Wide-field fundus photograph of an infant — 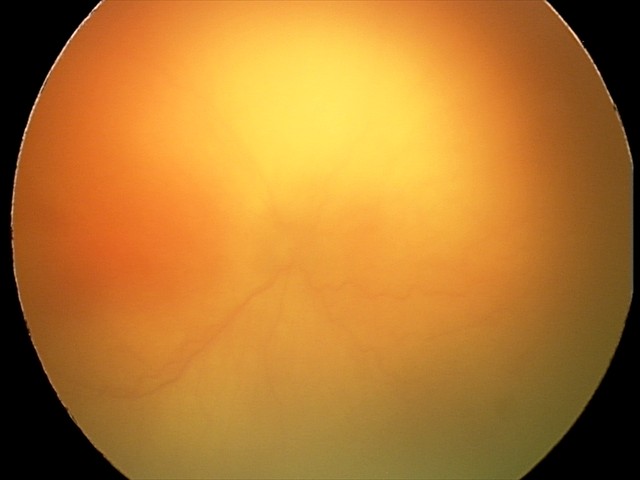

Examination diagnosed as aggressive retinopathy of prematurity. Plus disease present.